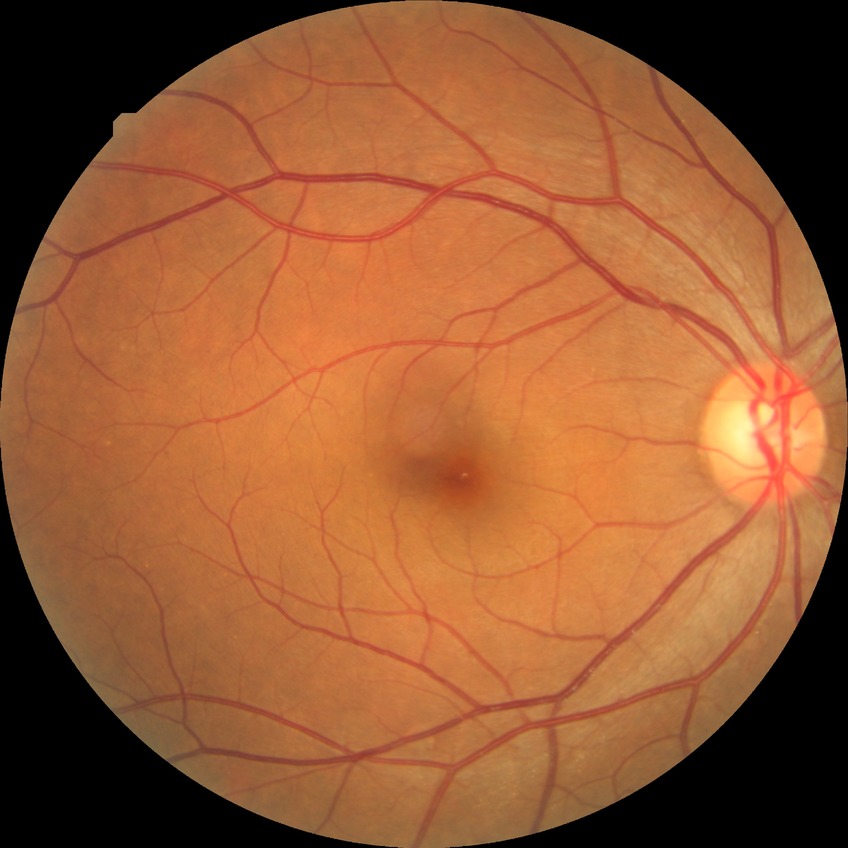 {
  "davis_grade": "no diabetic retinopathy (NDR)"
}